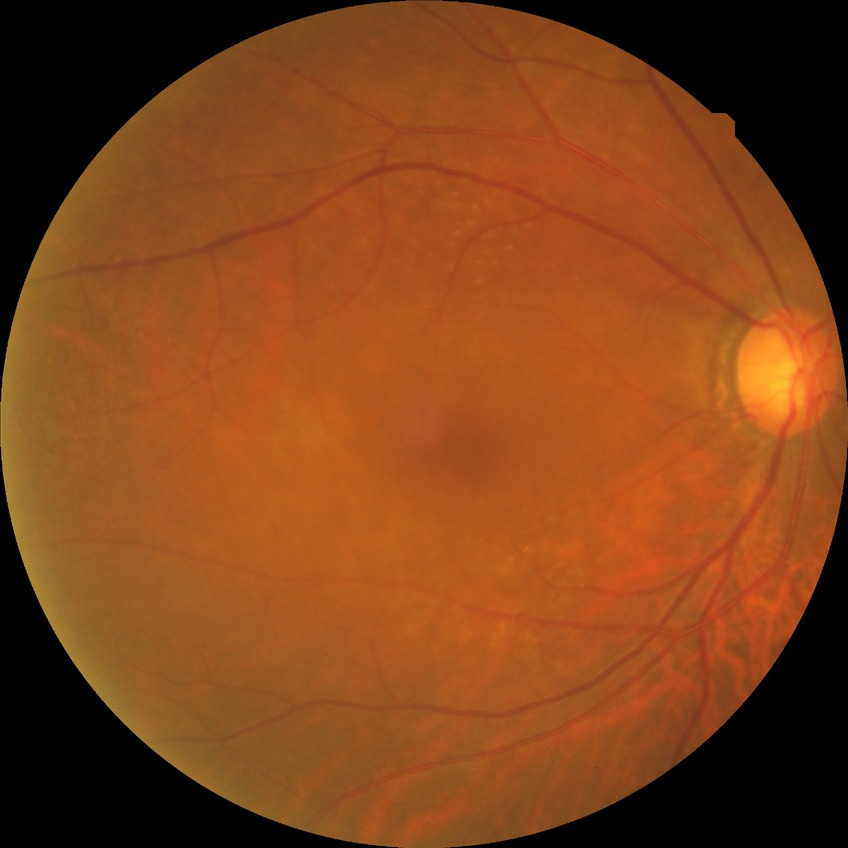

{"davis_grade": "NDR (no diabetic retinopathy)"}